FOV: 45 degrees; 2212 by 1659 pixels:
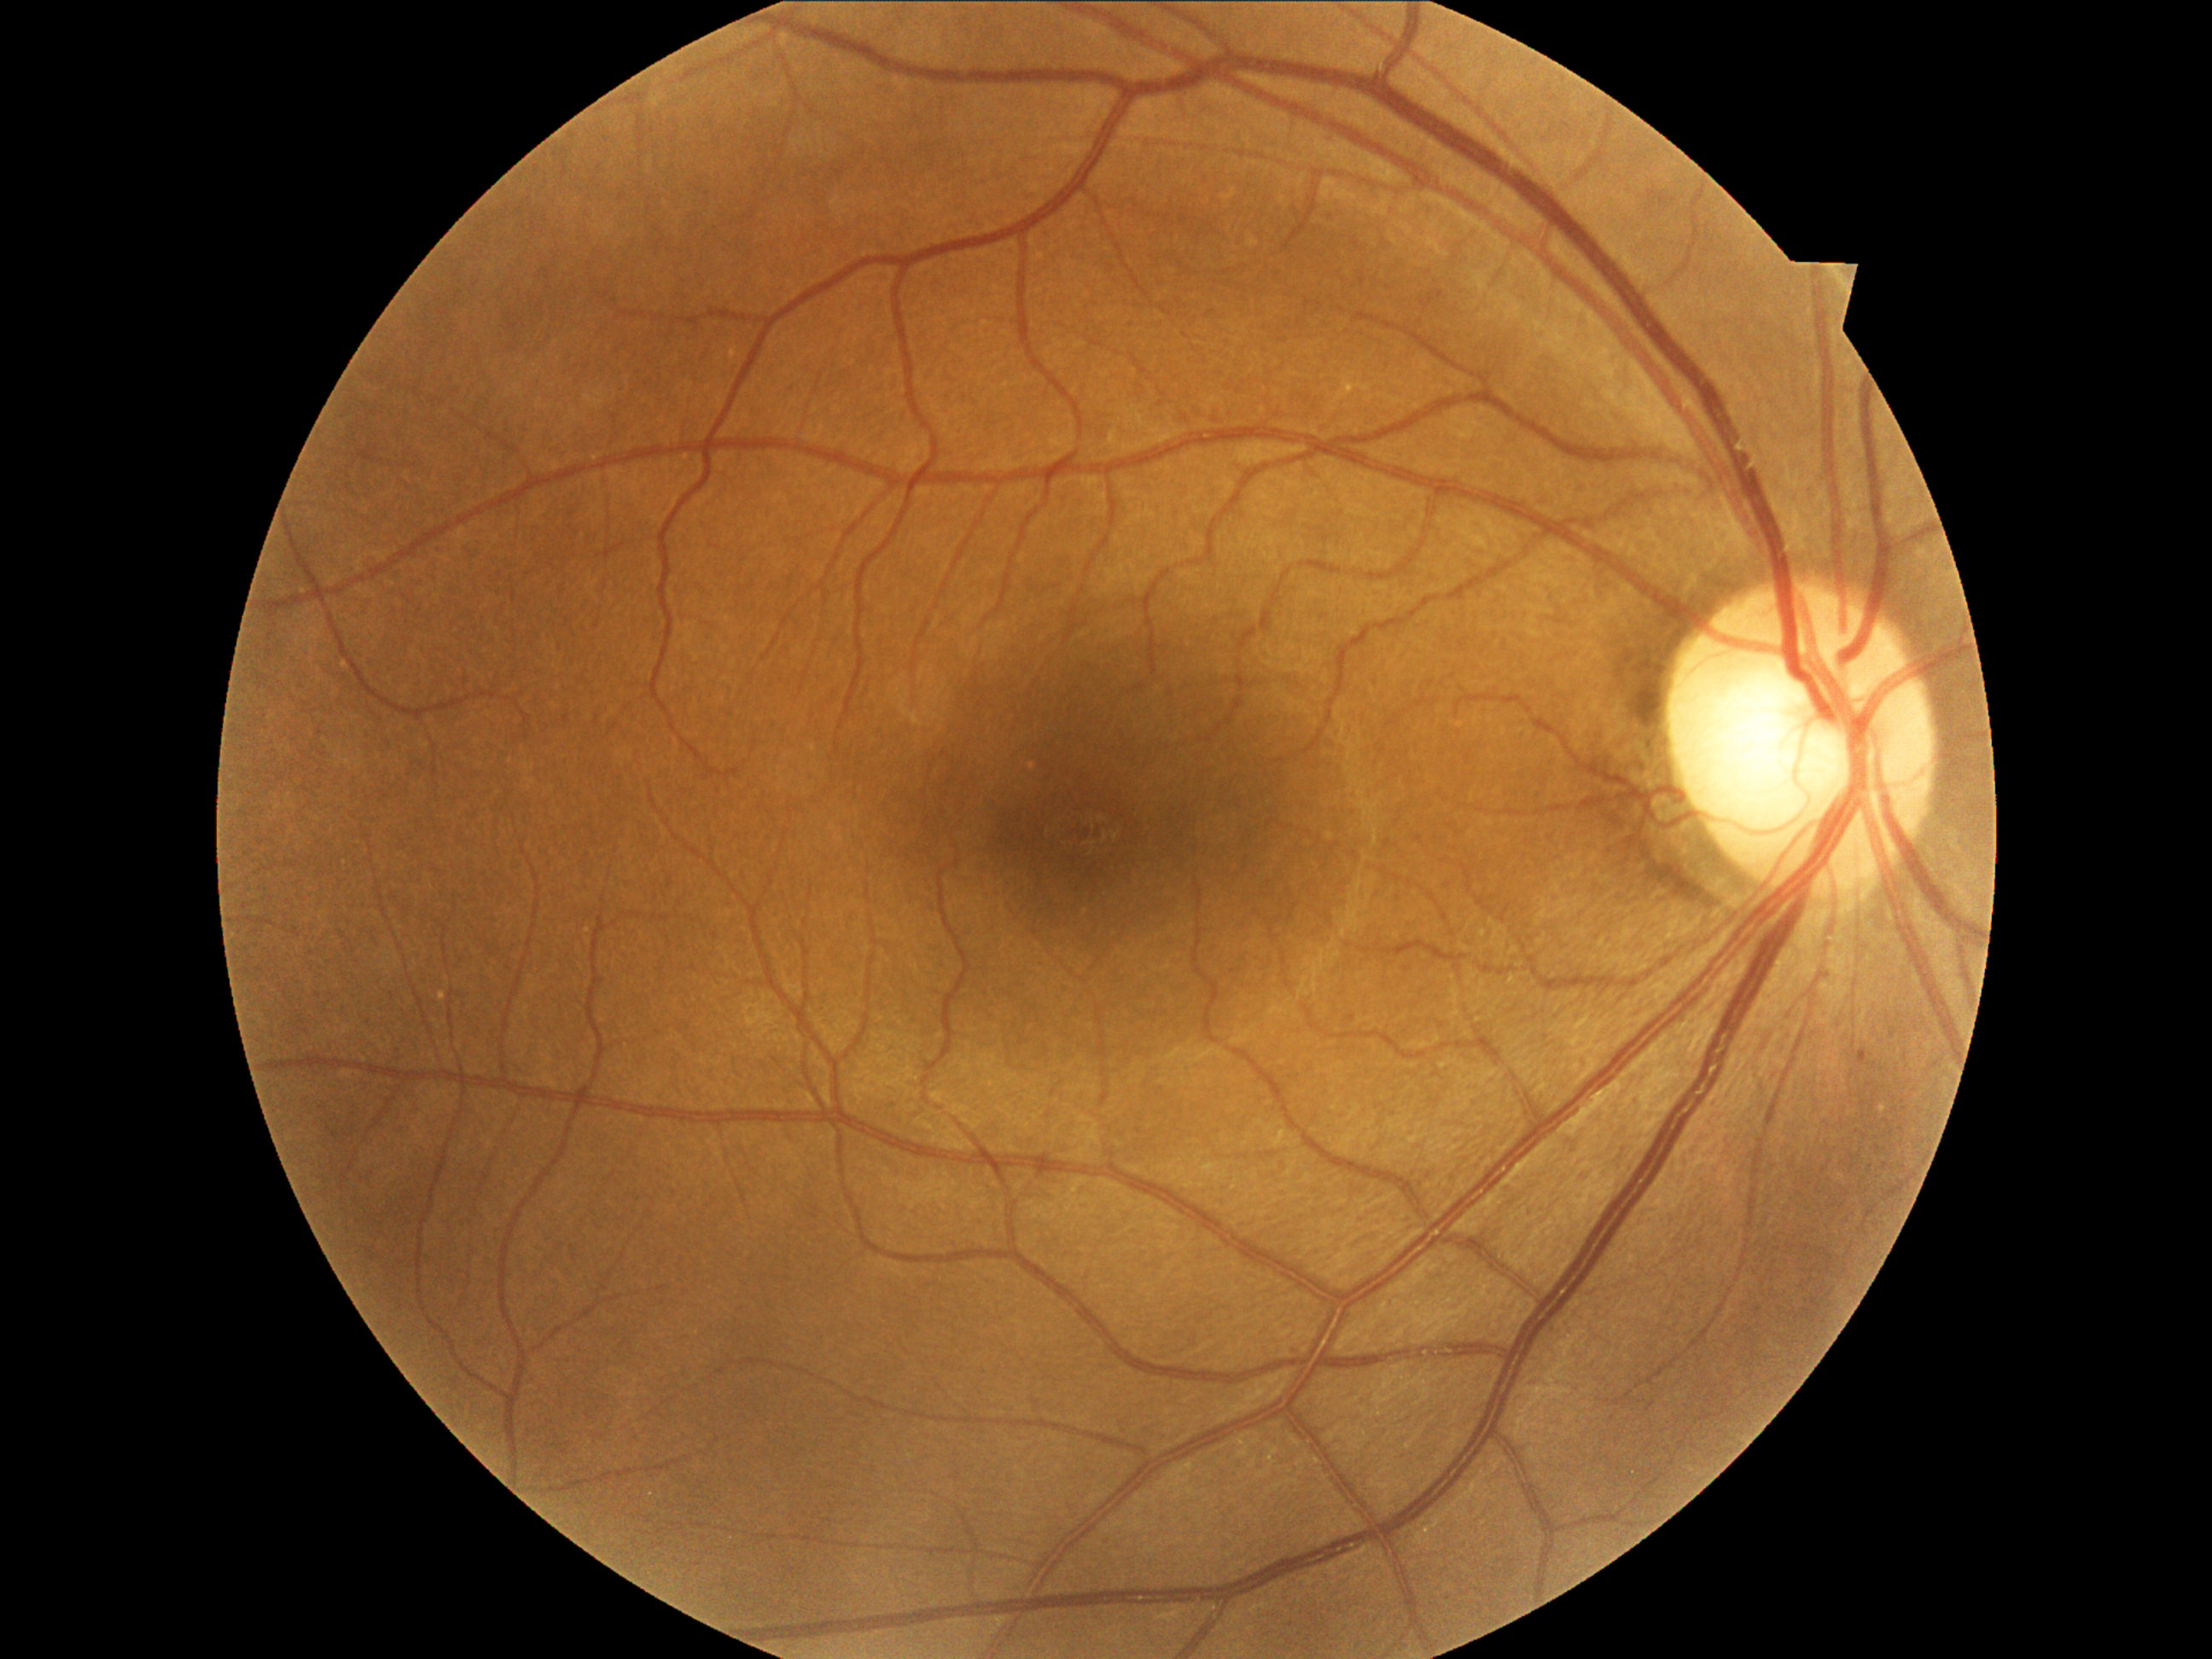
Annotations:
* diabetic retinopathy: grade 1 (mild NPDR)